Retinal fundus photograph · image size 2352x1568 · 45° field of view: 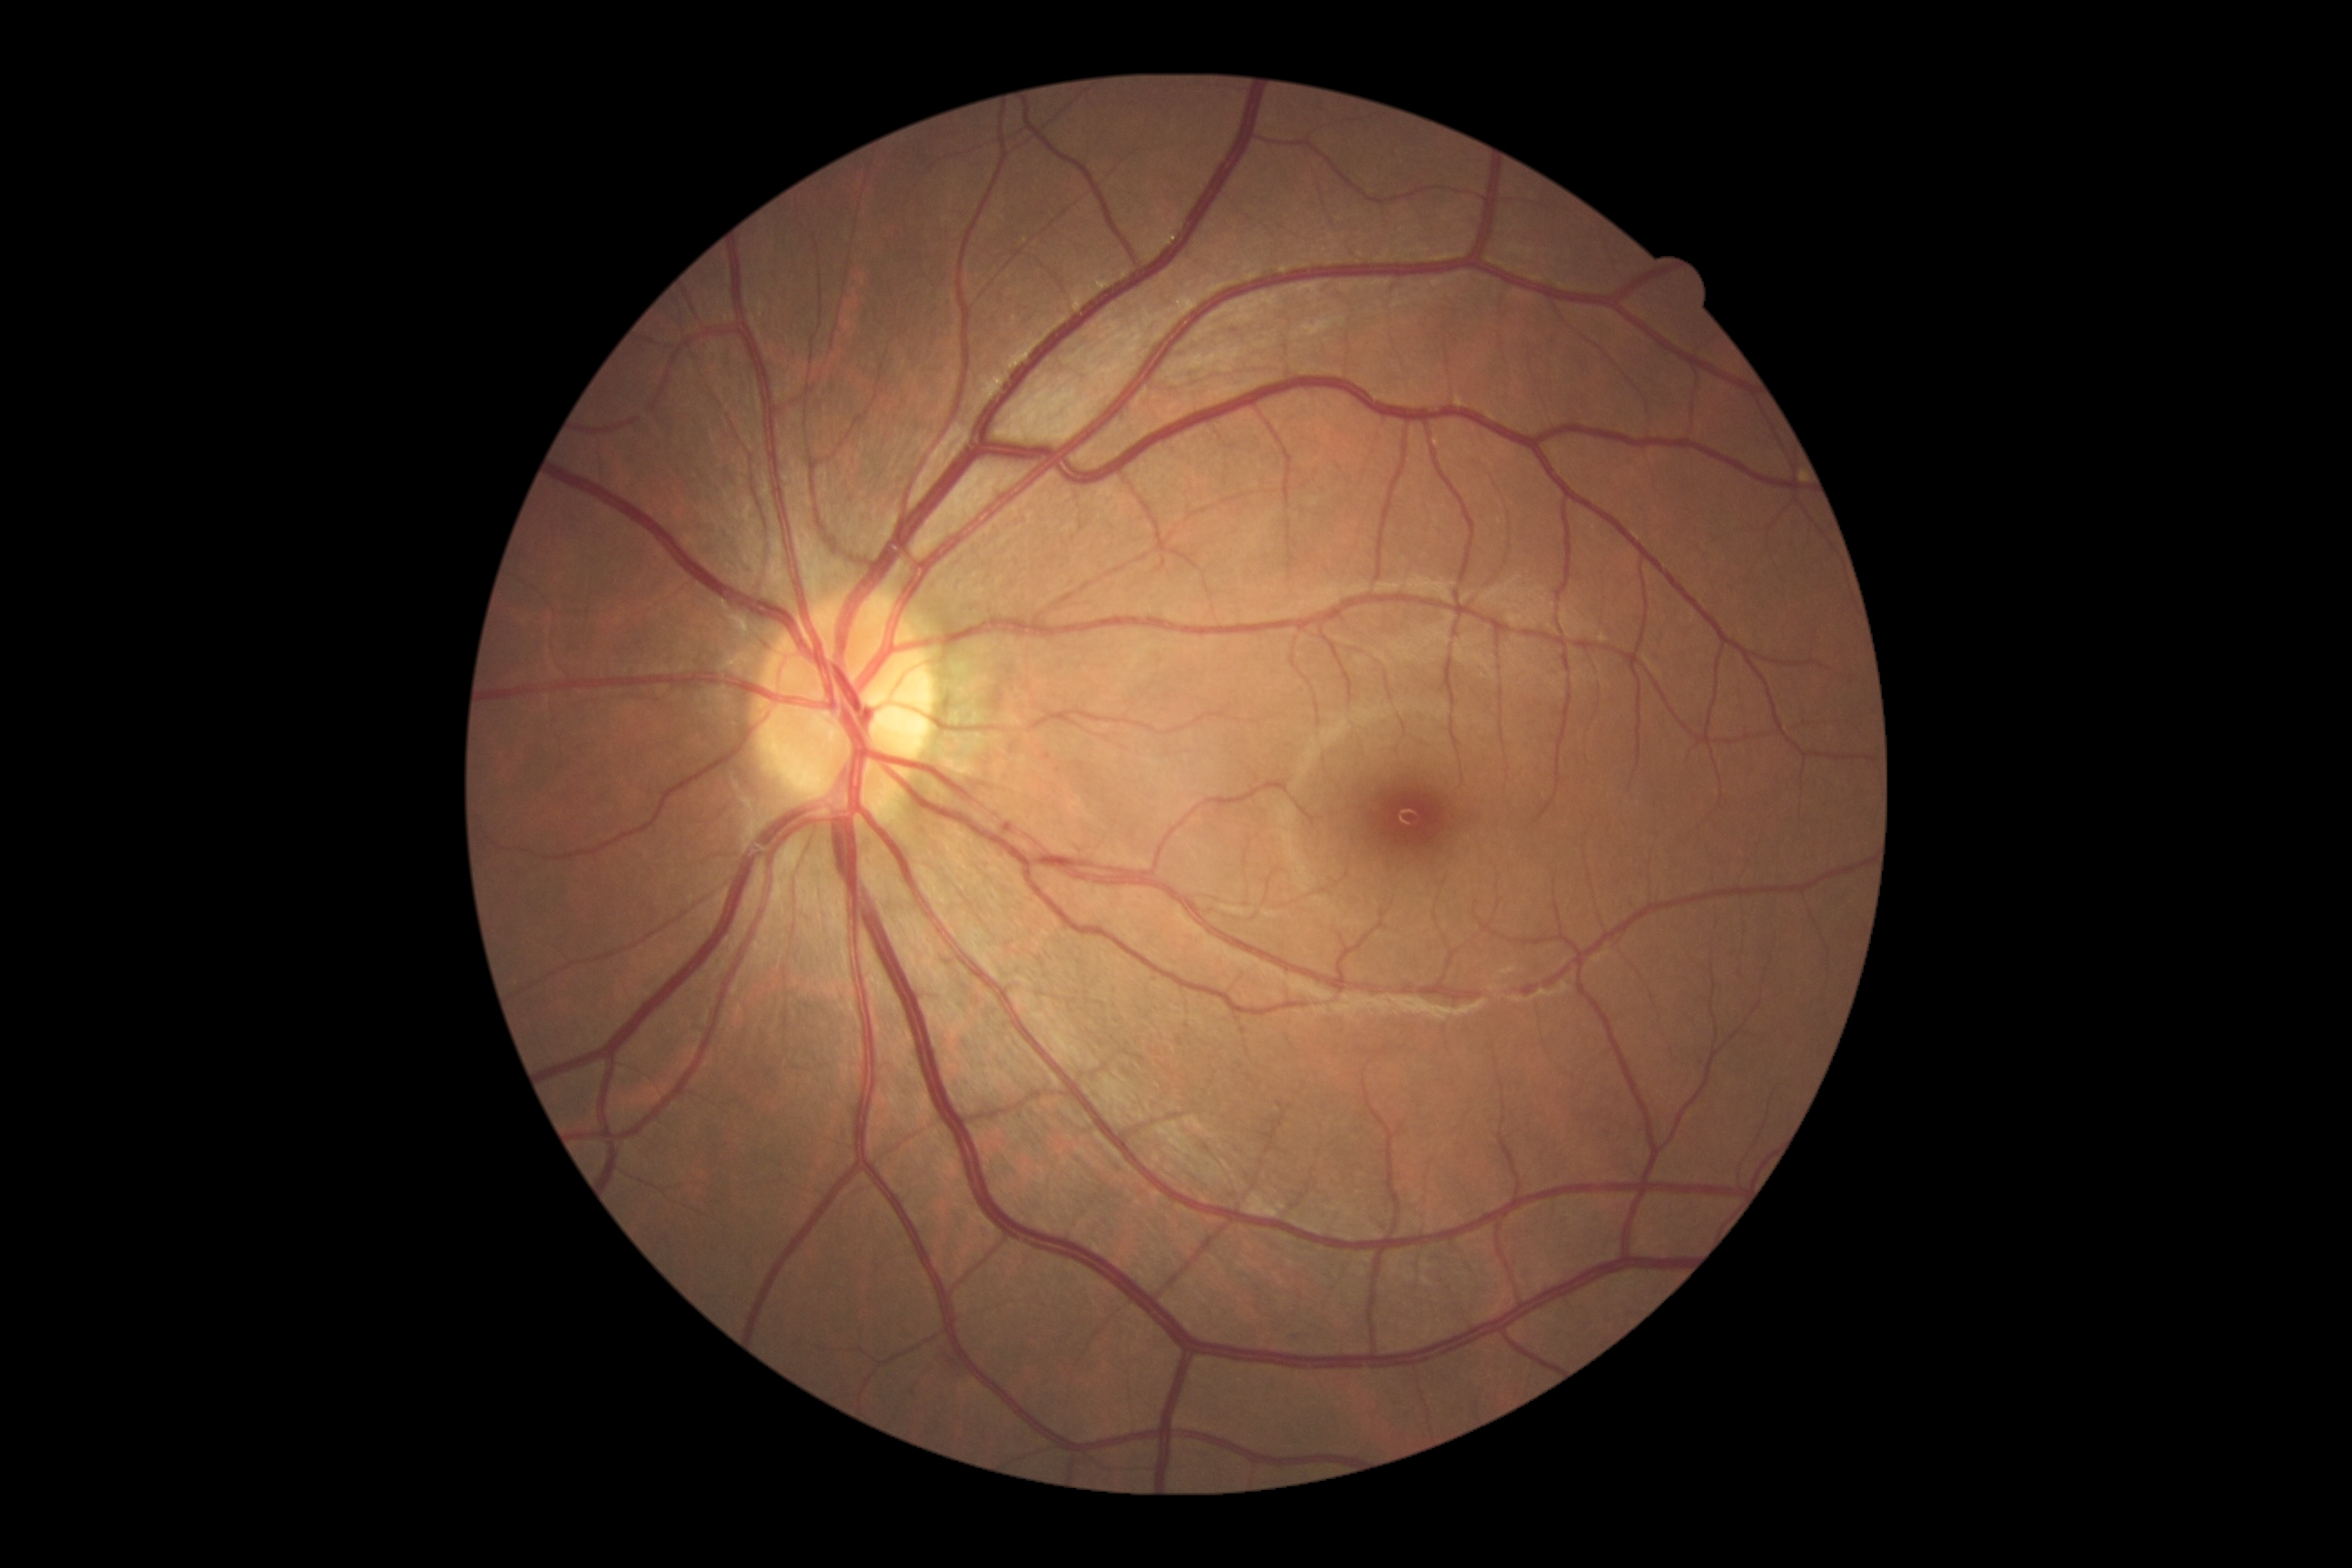

No DR findings. Diabetic retinopathy (DR) is 0 — no visible signs of diabetic retinopathy.